Color fundus image
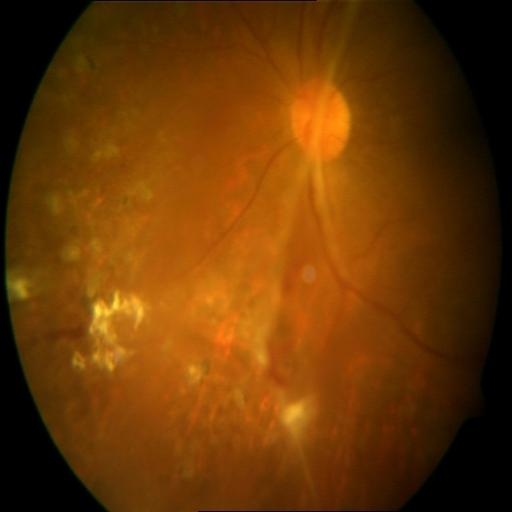
Findings: retinal traction, exudation.